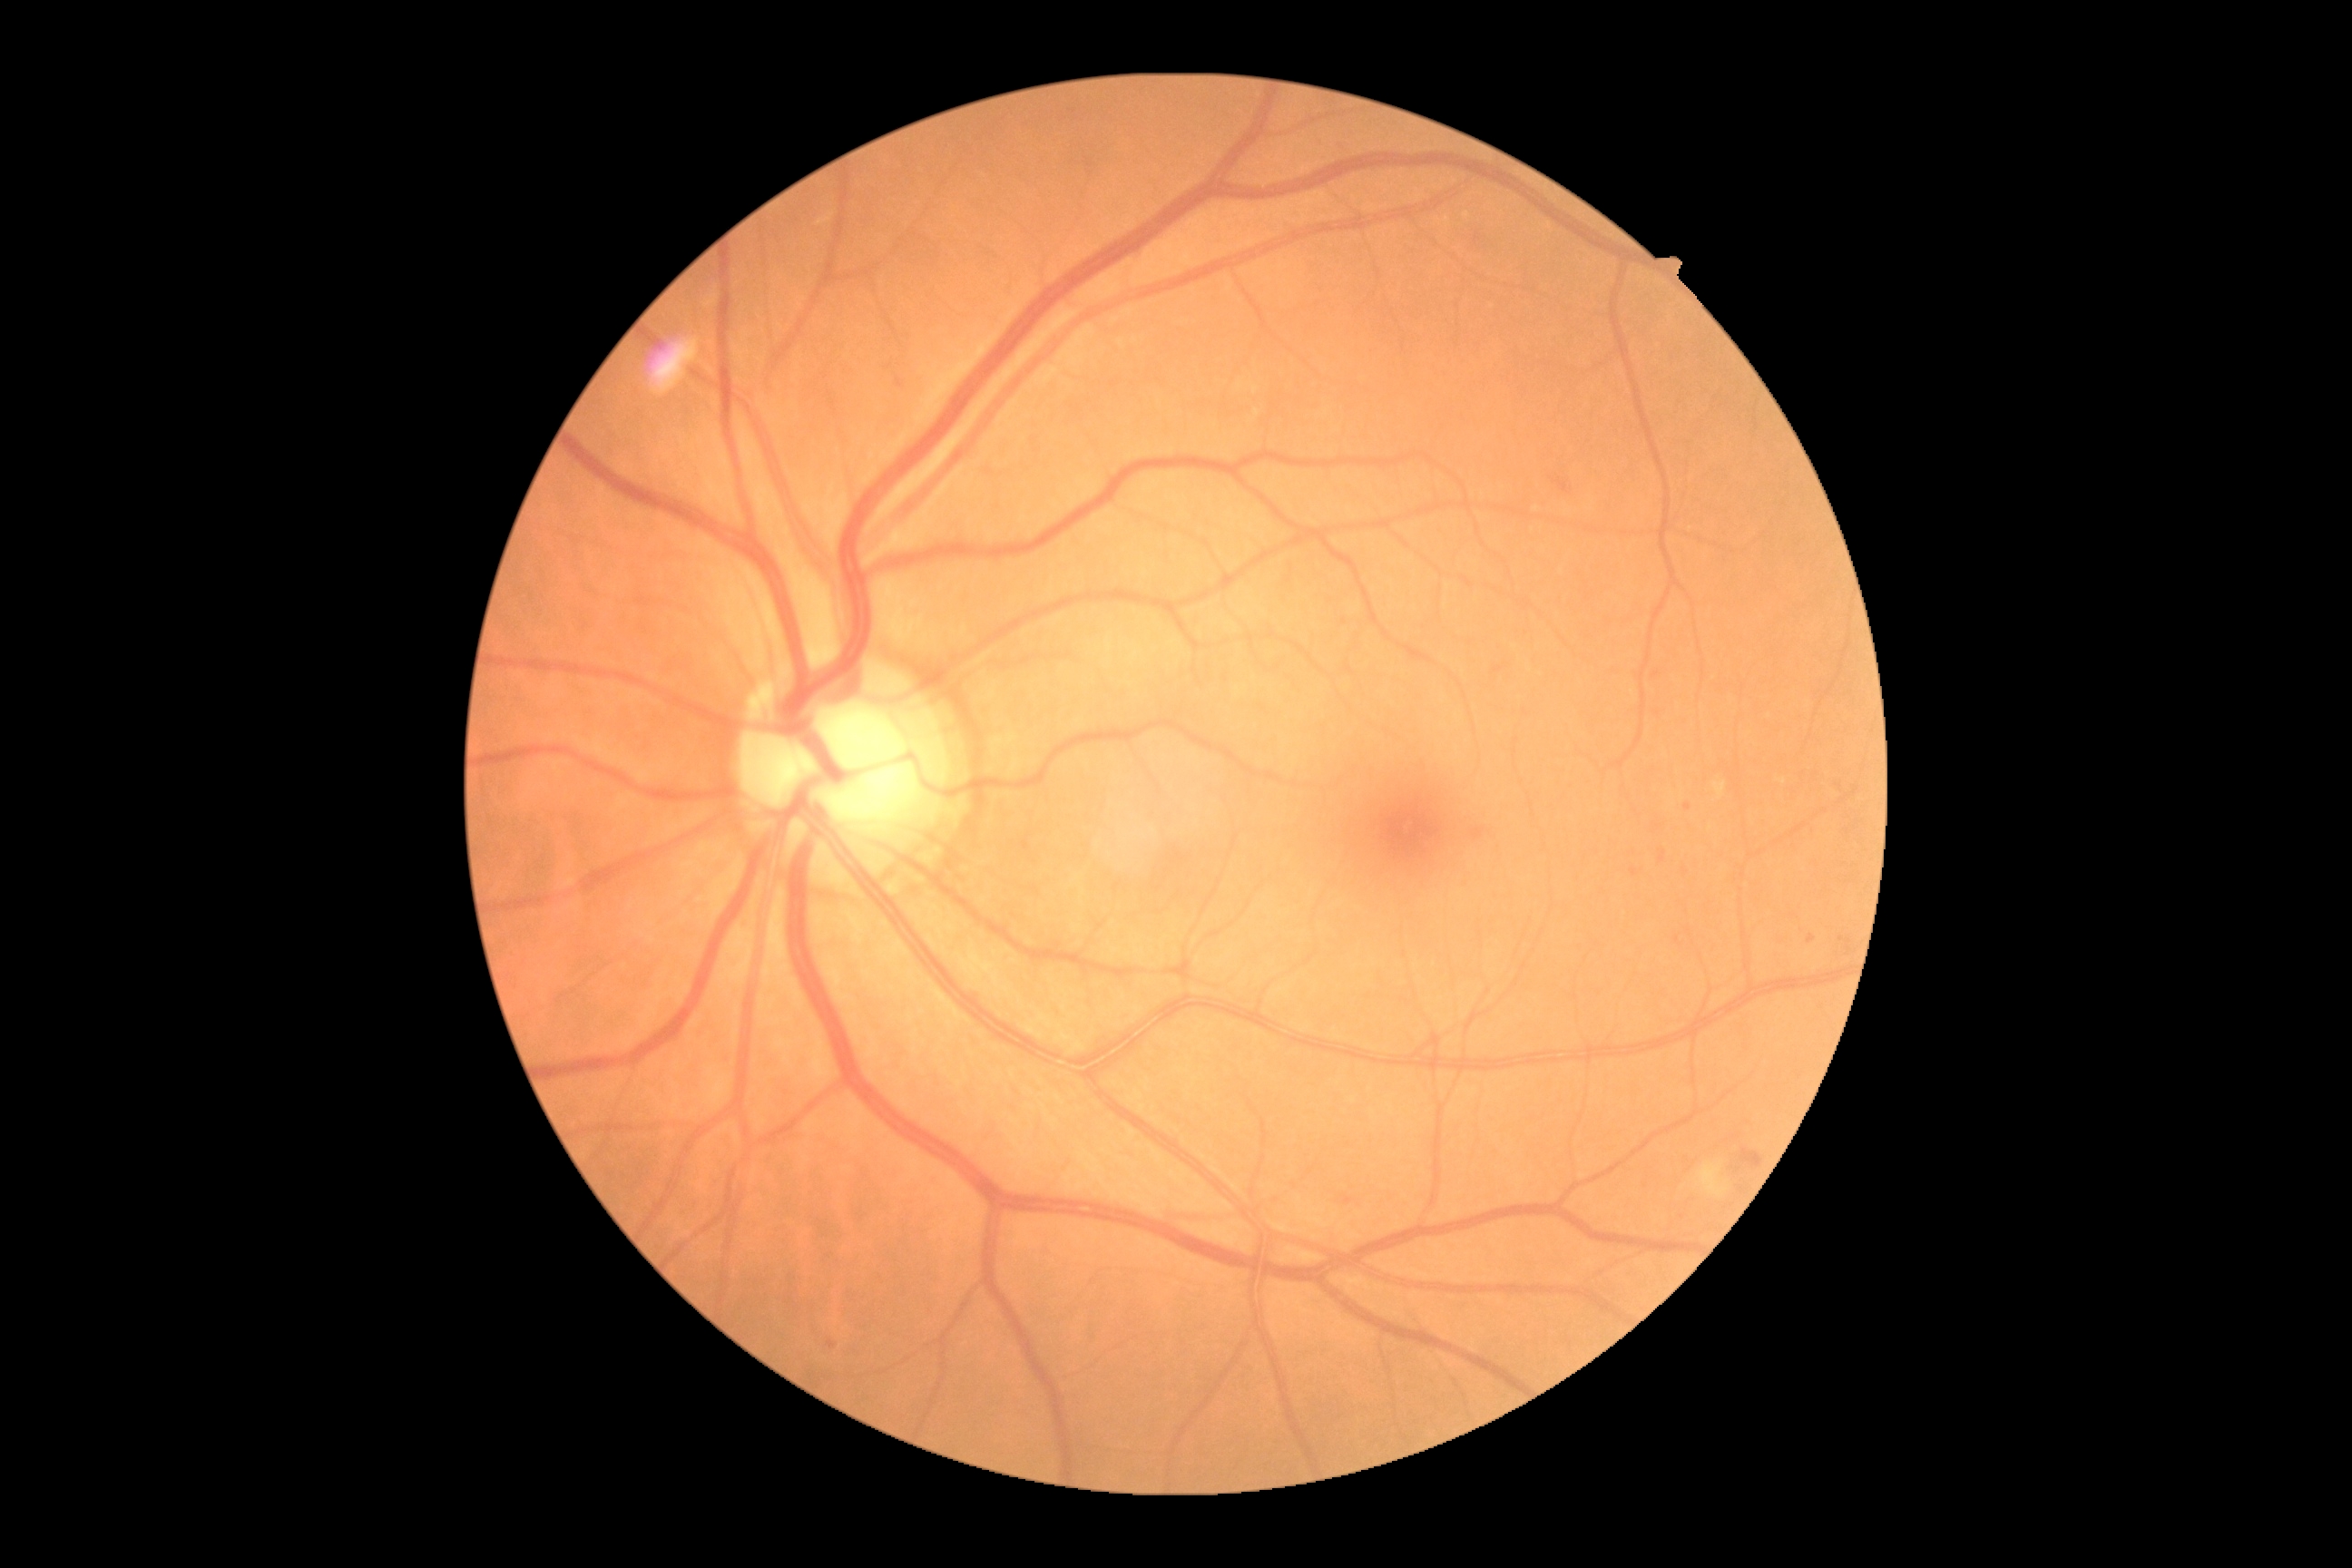 DR stage: 2/4.